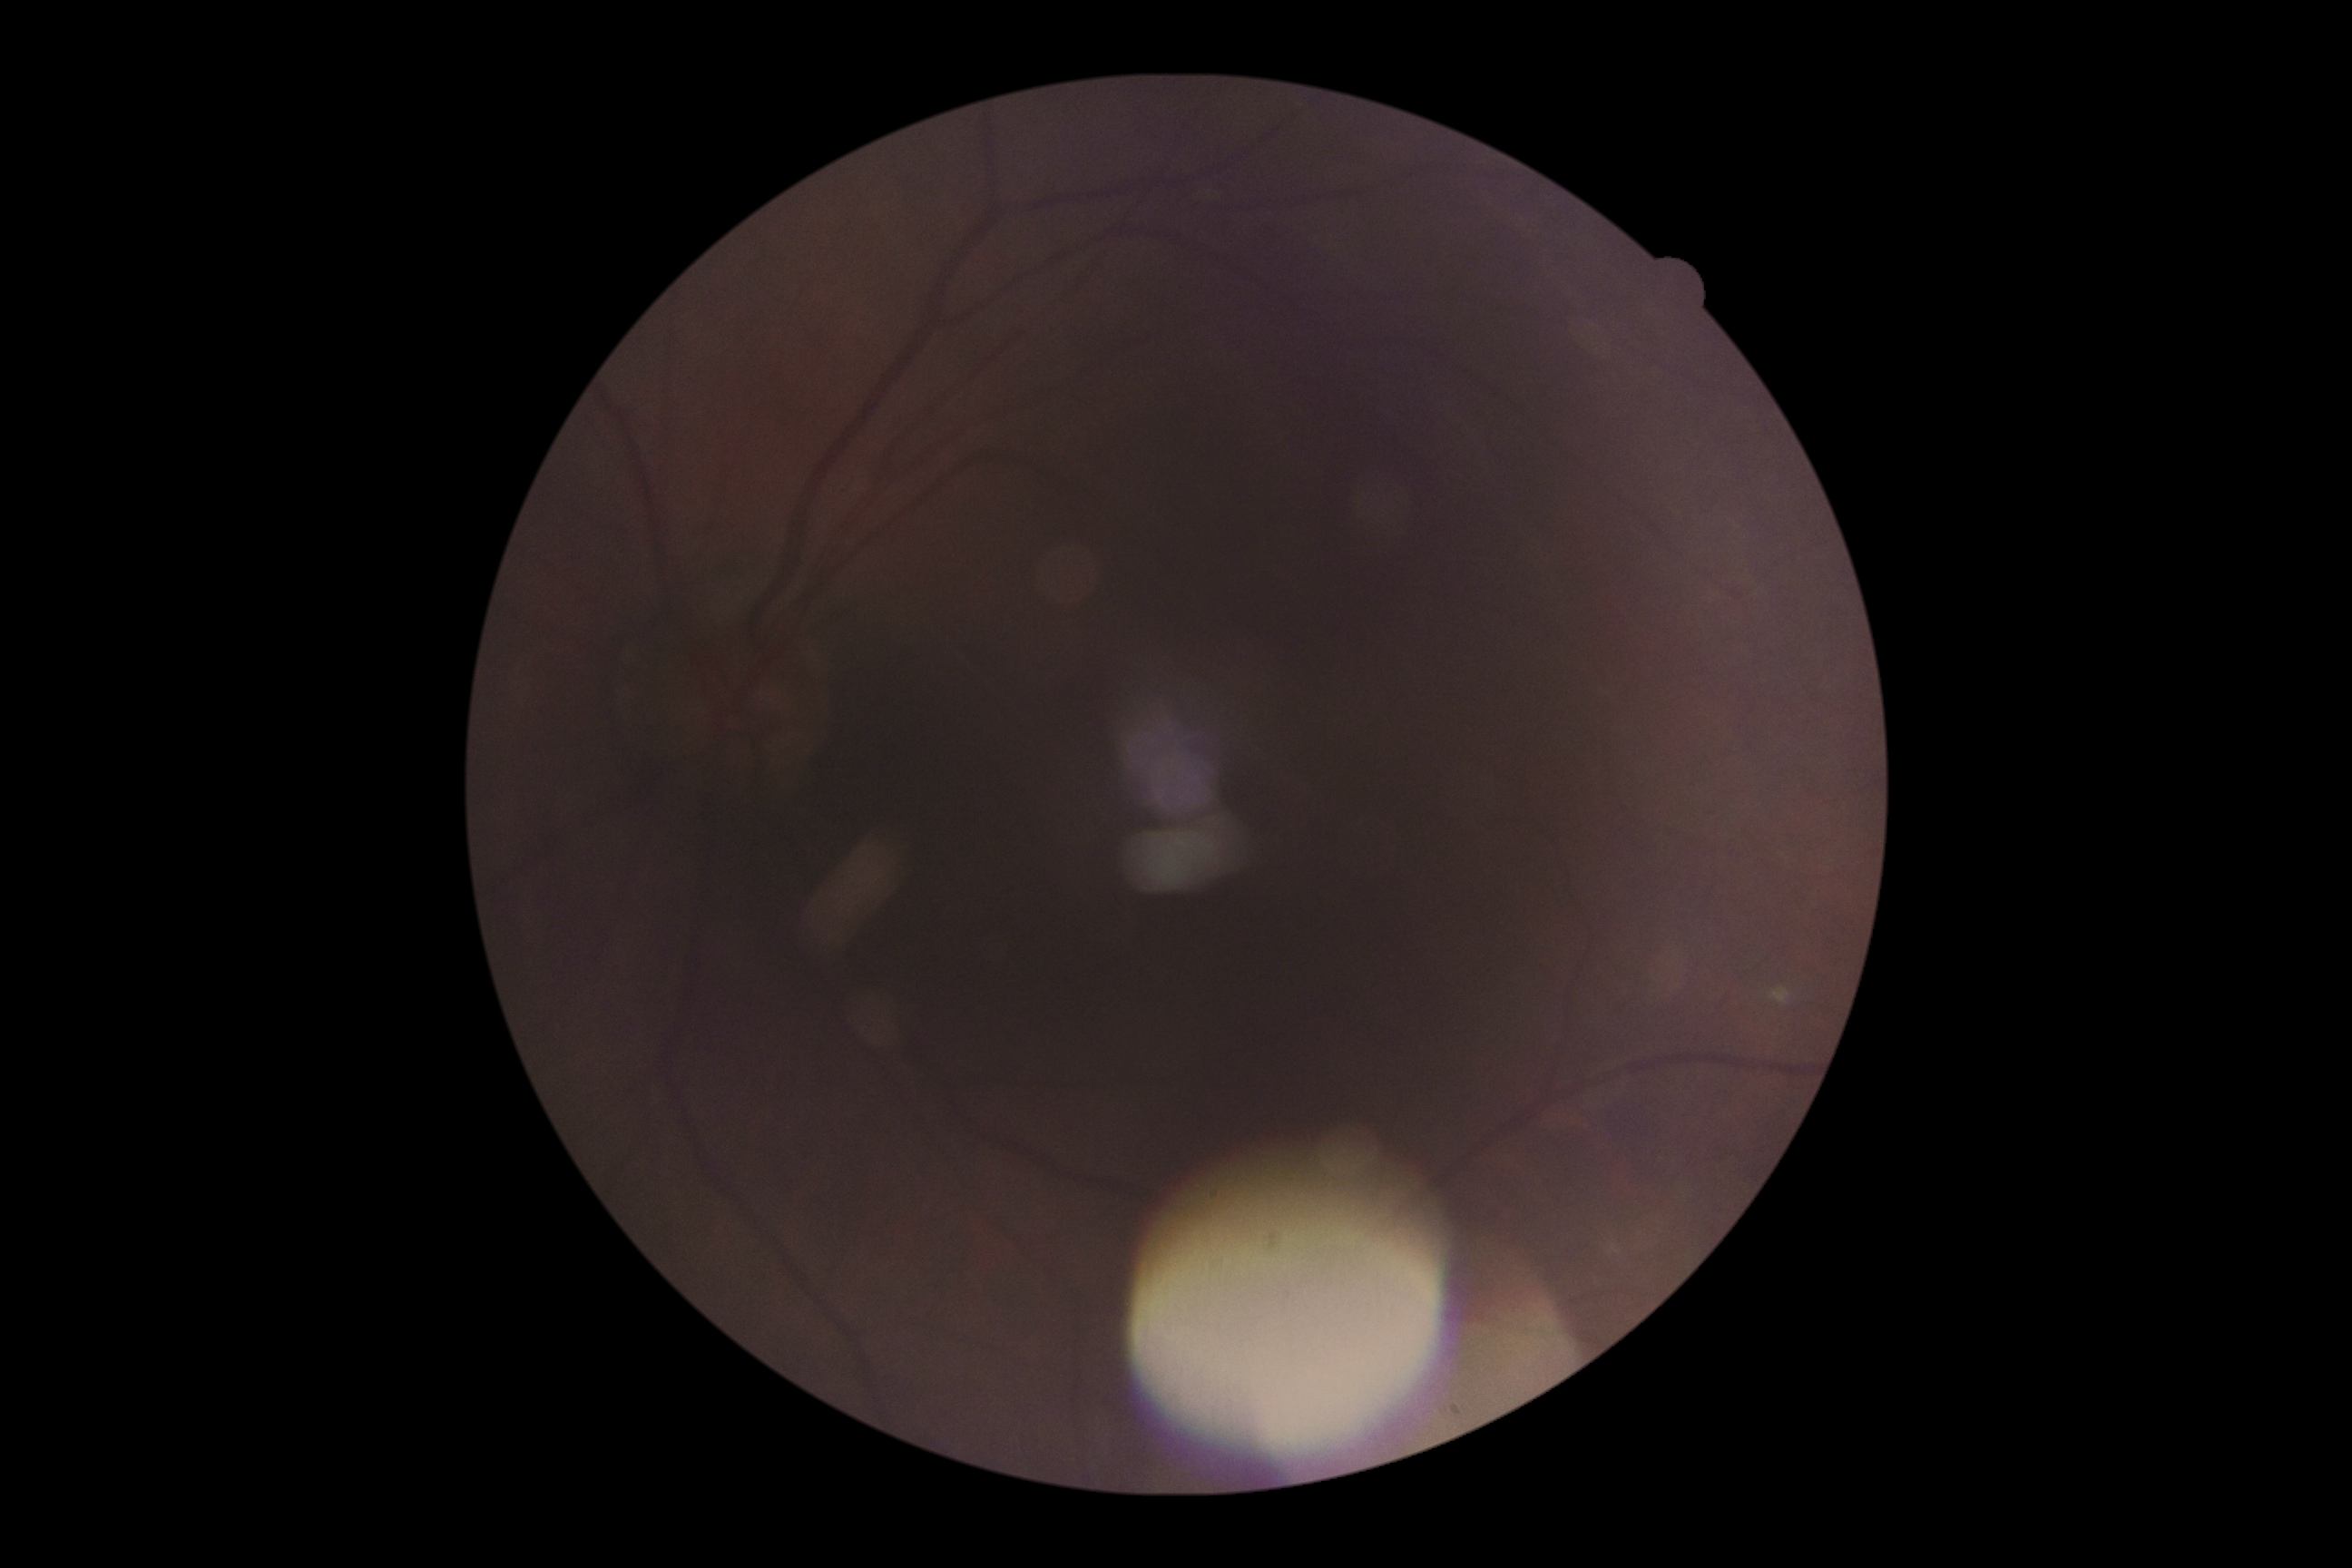
diabetic retinopathy (DR): 0.